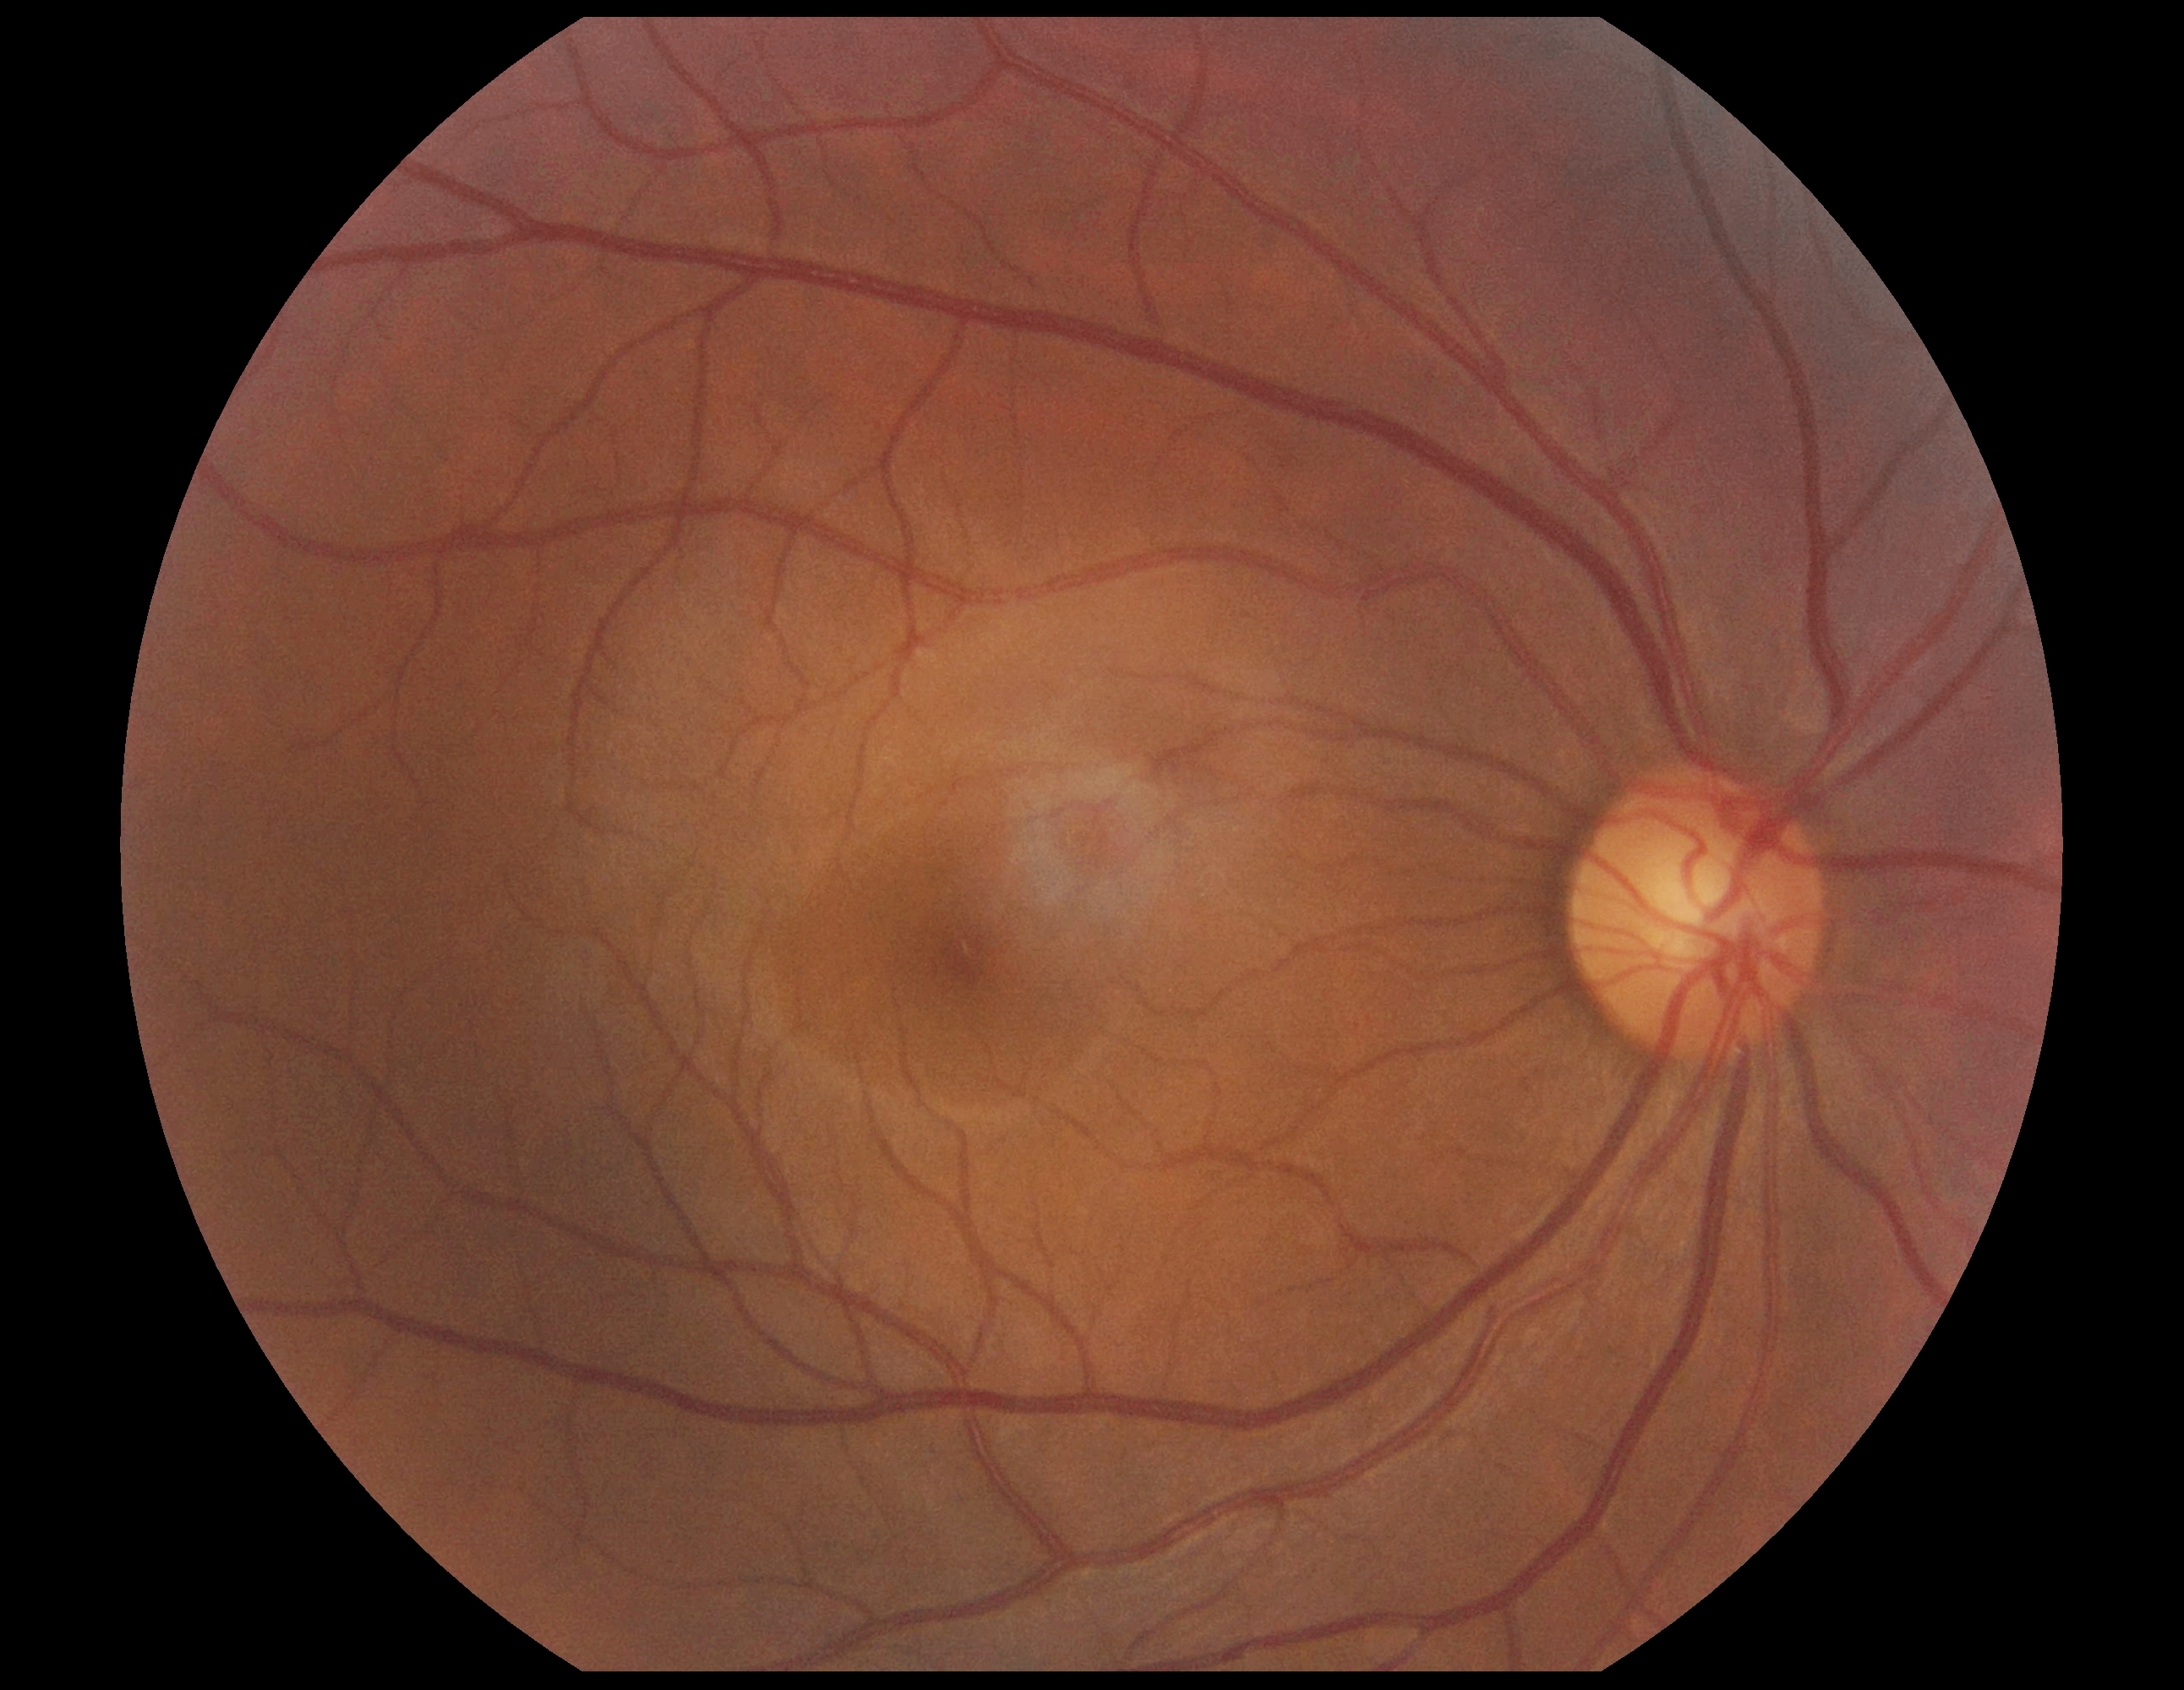

Retinopathy is grade 0.